Modified Davis grading — 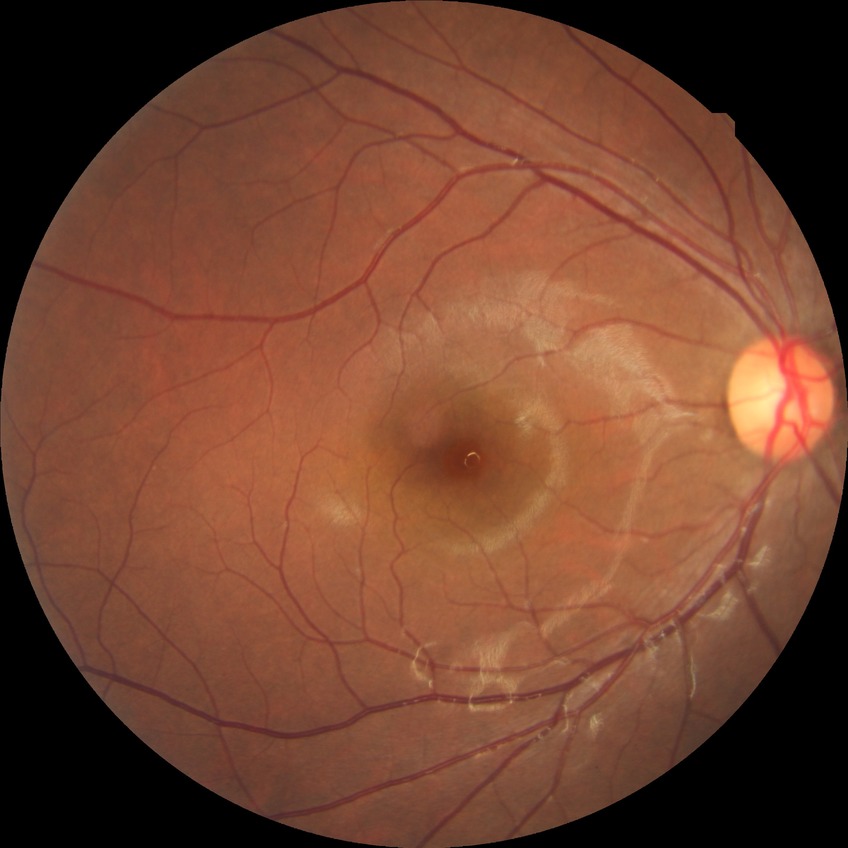 Assessment:
- retinopathy stage — no diabetic retinopathy